512 by 512 pixels — 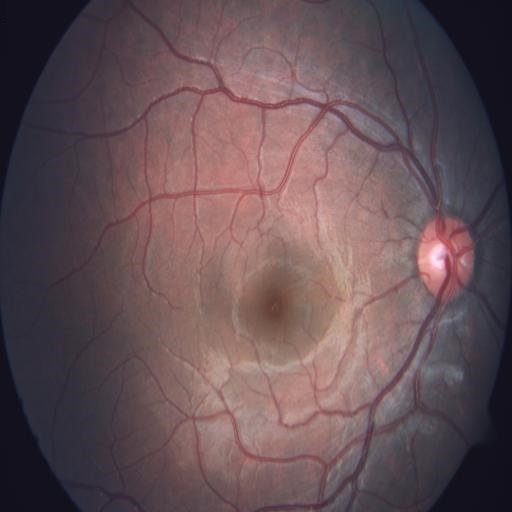 No abnormal findings on fundus examination.